Infant wide-field retinal image: 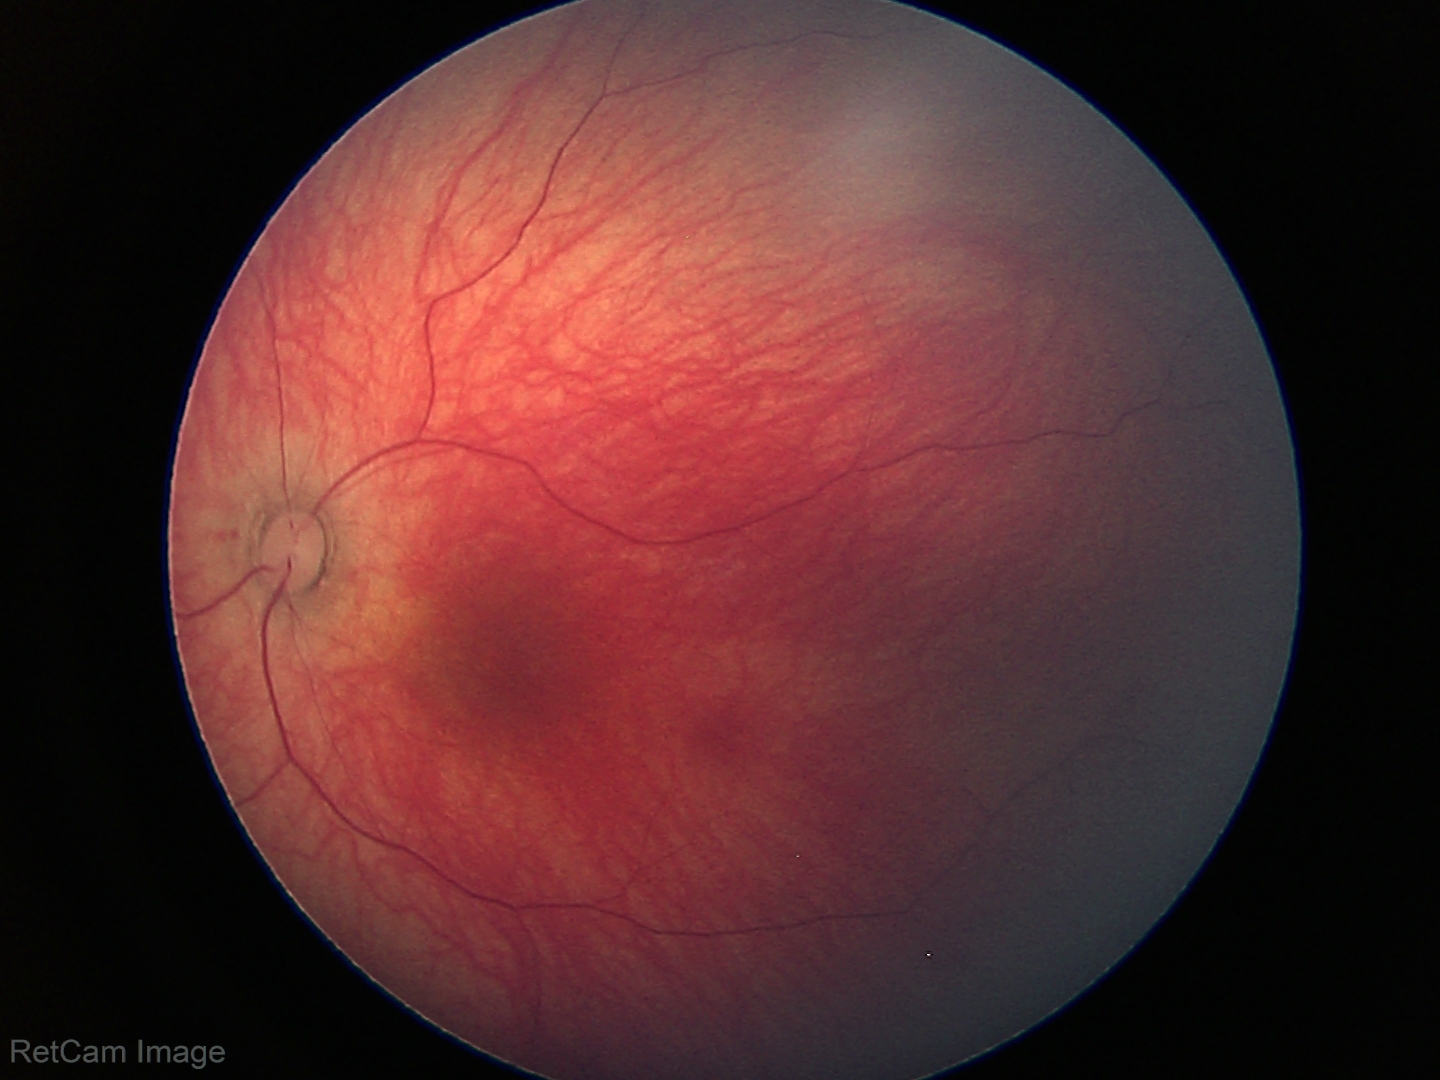 Normal screening examination.